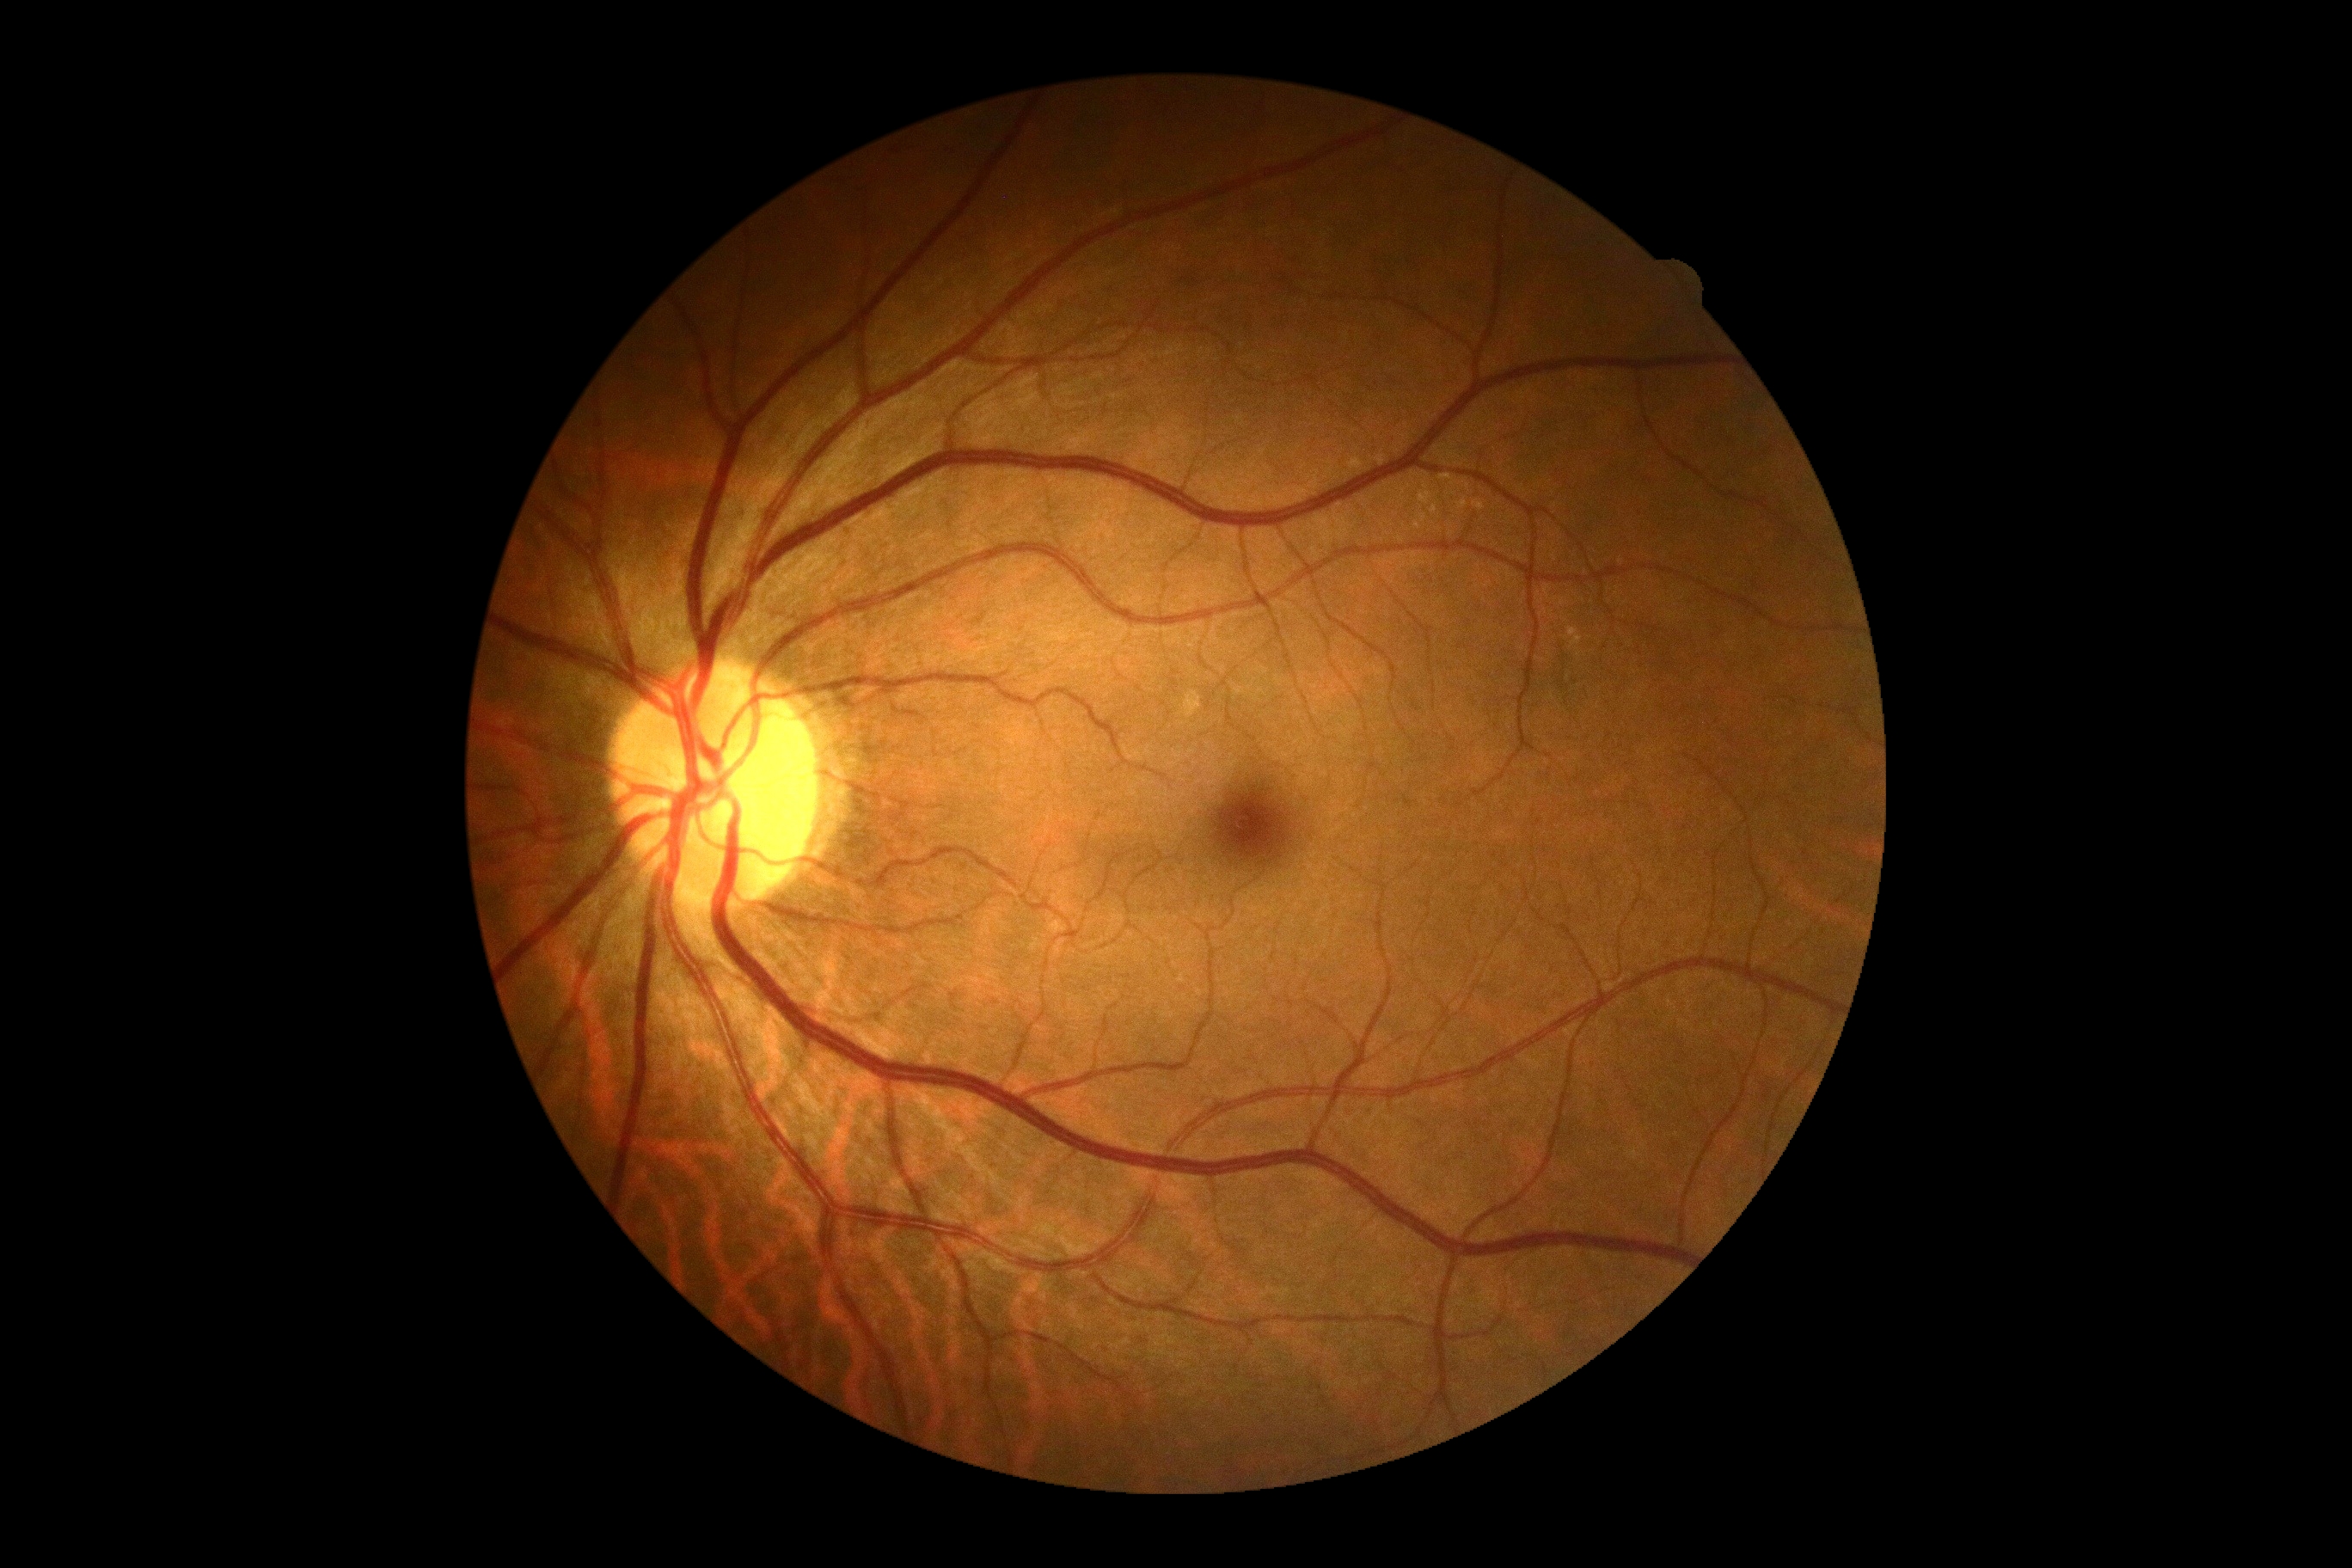

Findings:
– diabetic retinopathy (DR): 0/4
– DR impression: no DR findings